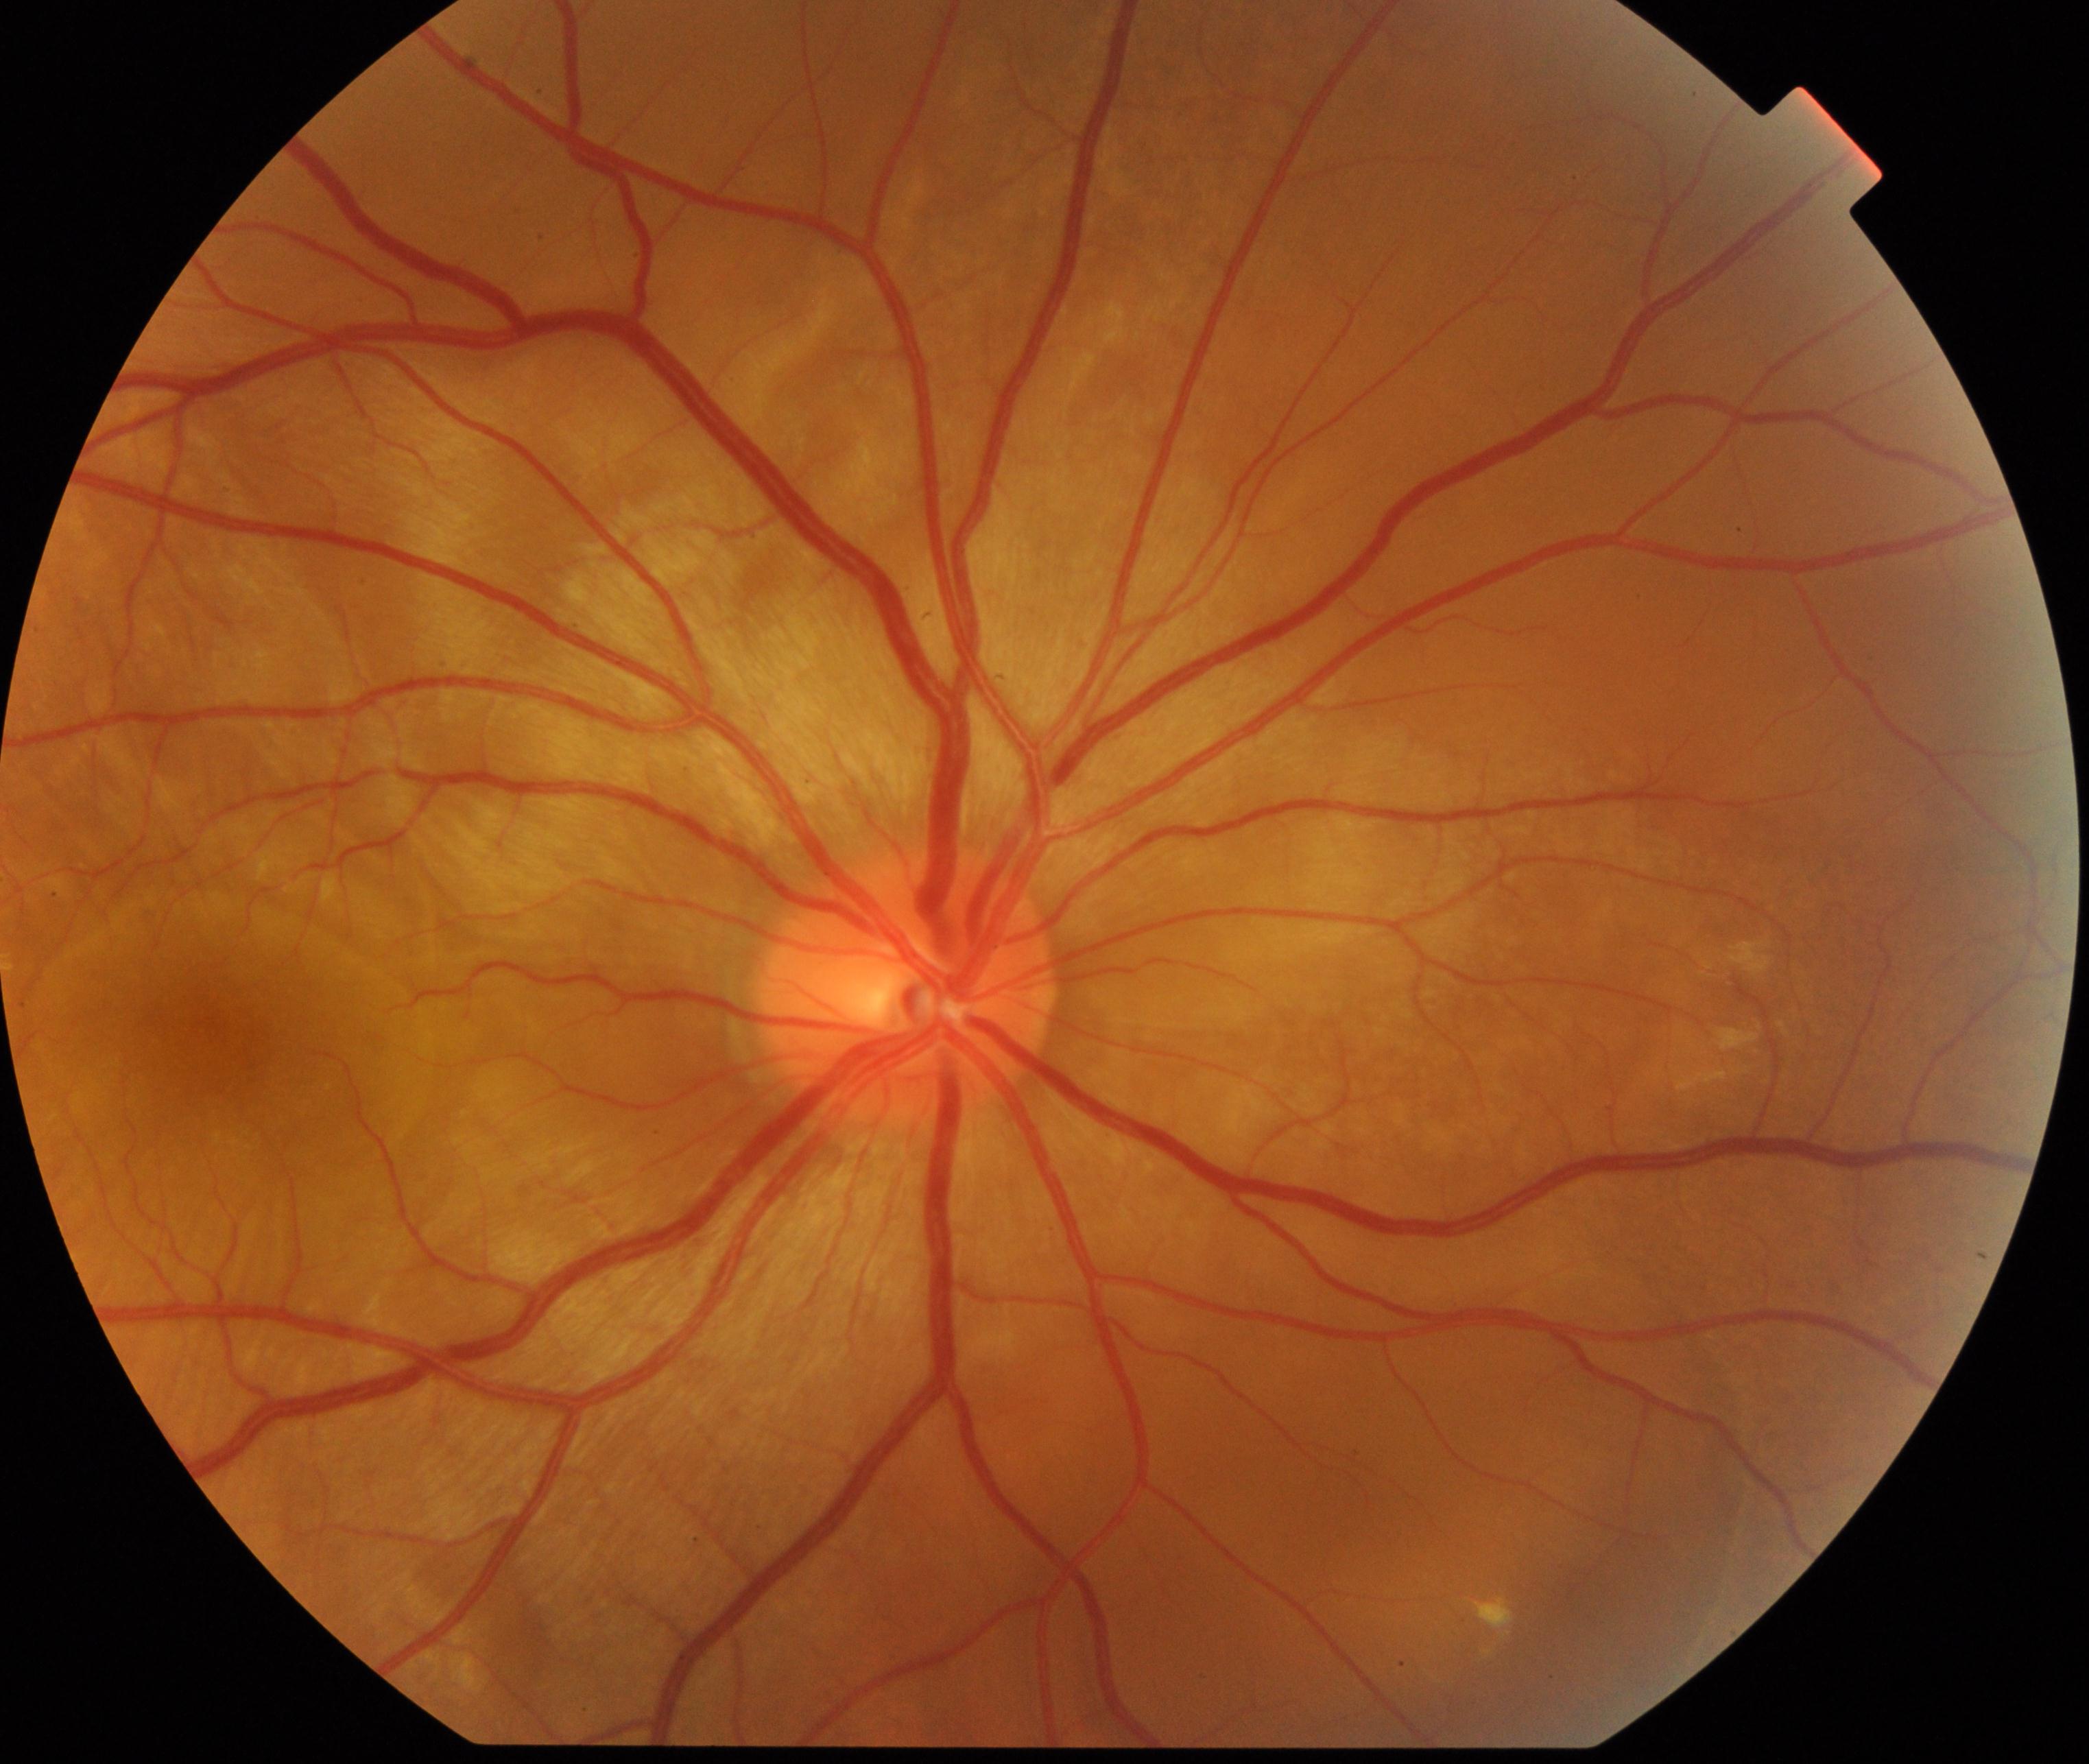

Findings: Vogt-Koyanagi-Harada disease.